Nonmydriatic fundus photograph · posterior pole color fundus photograph.
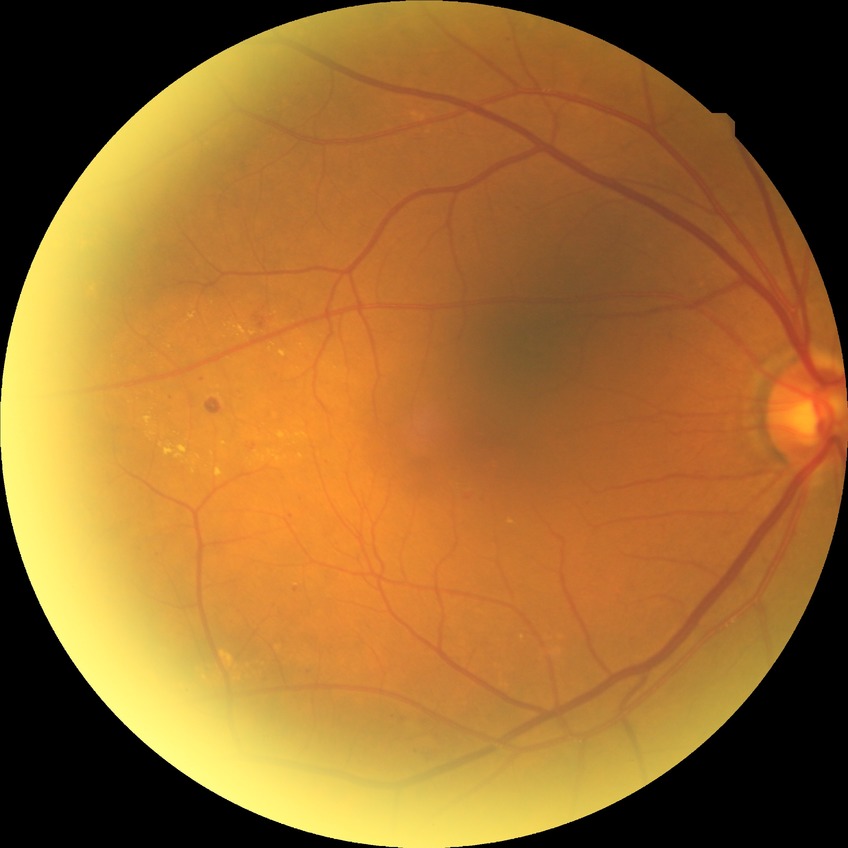
diabetic retinopathy (DR): simple diabetic retinopathy (SDR).